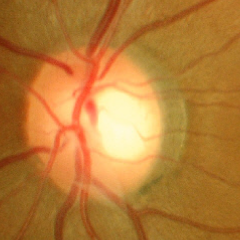 Optic nerve head appearance consistent with no glaucomatous findings.